Wide-field contact fundus photograph of an infant
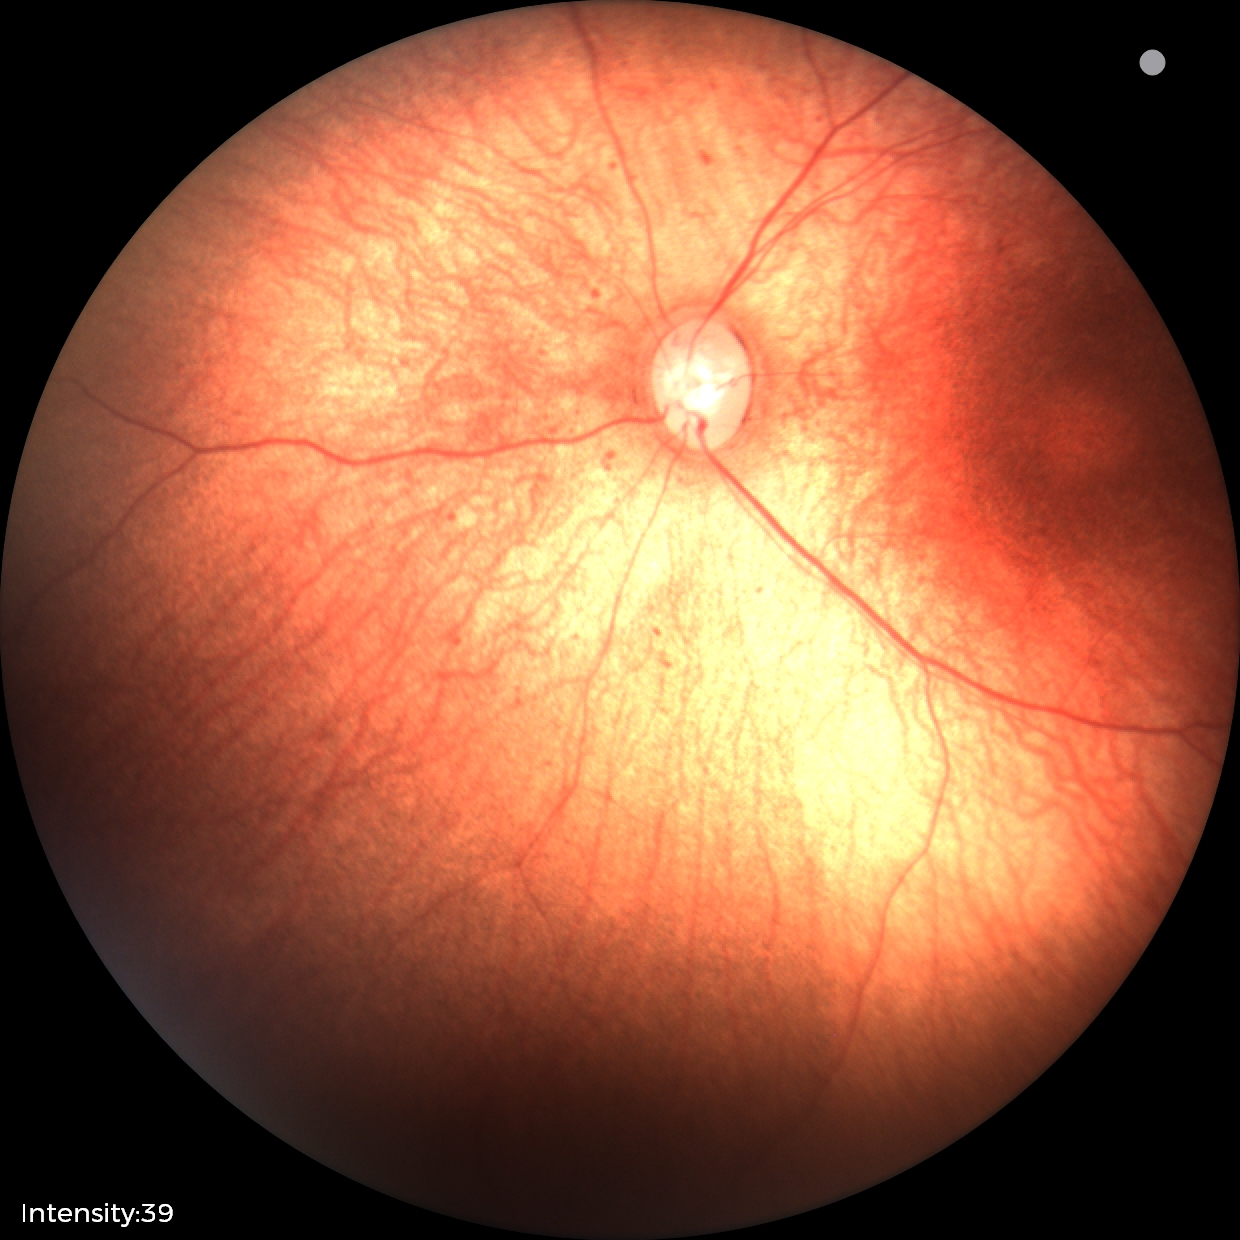
No retinal pathology identified on screening.